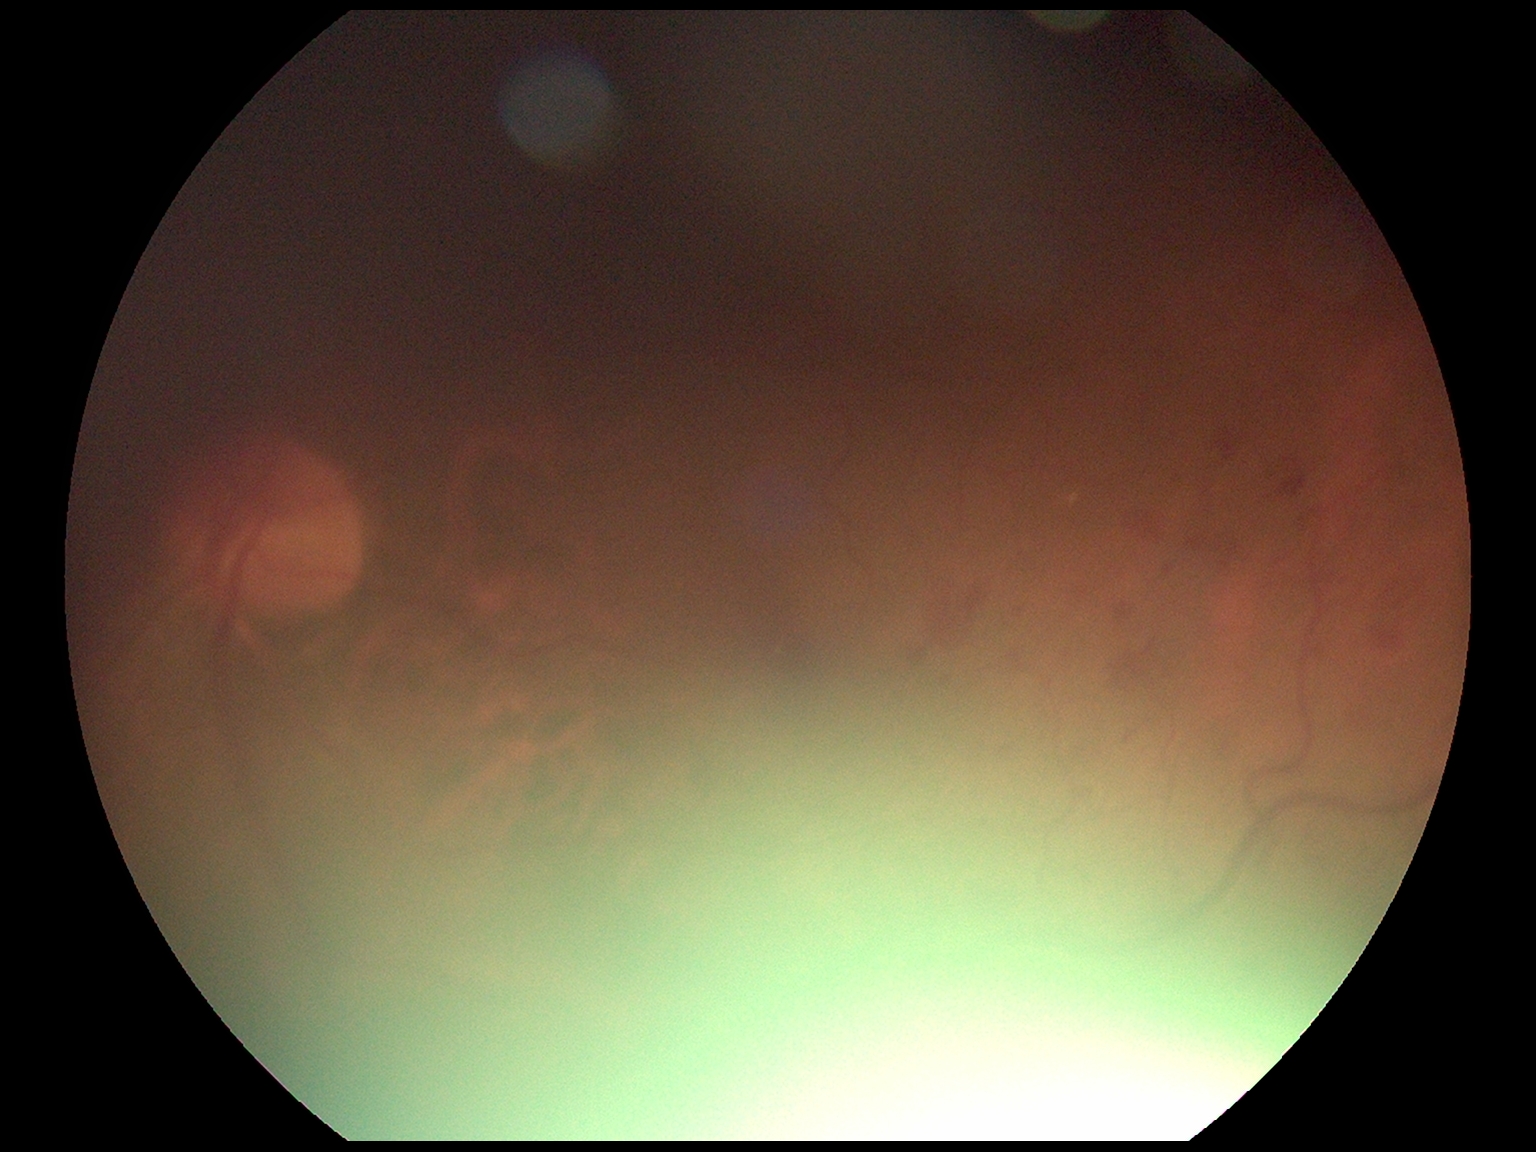
Findings:
- DR grade — moderate NPDR (2)